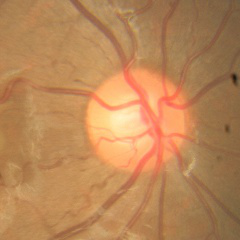
Impression = no glaucoma.